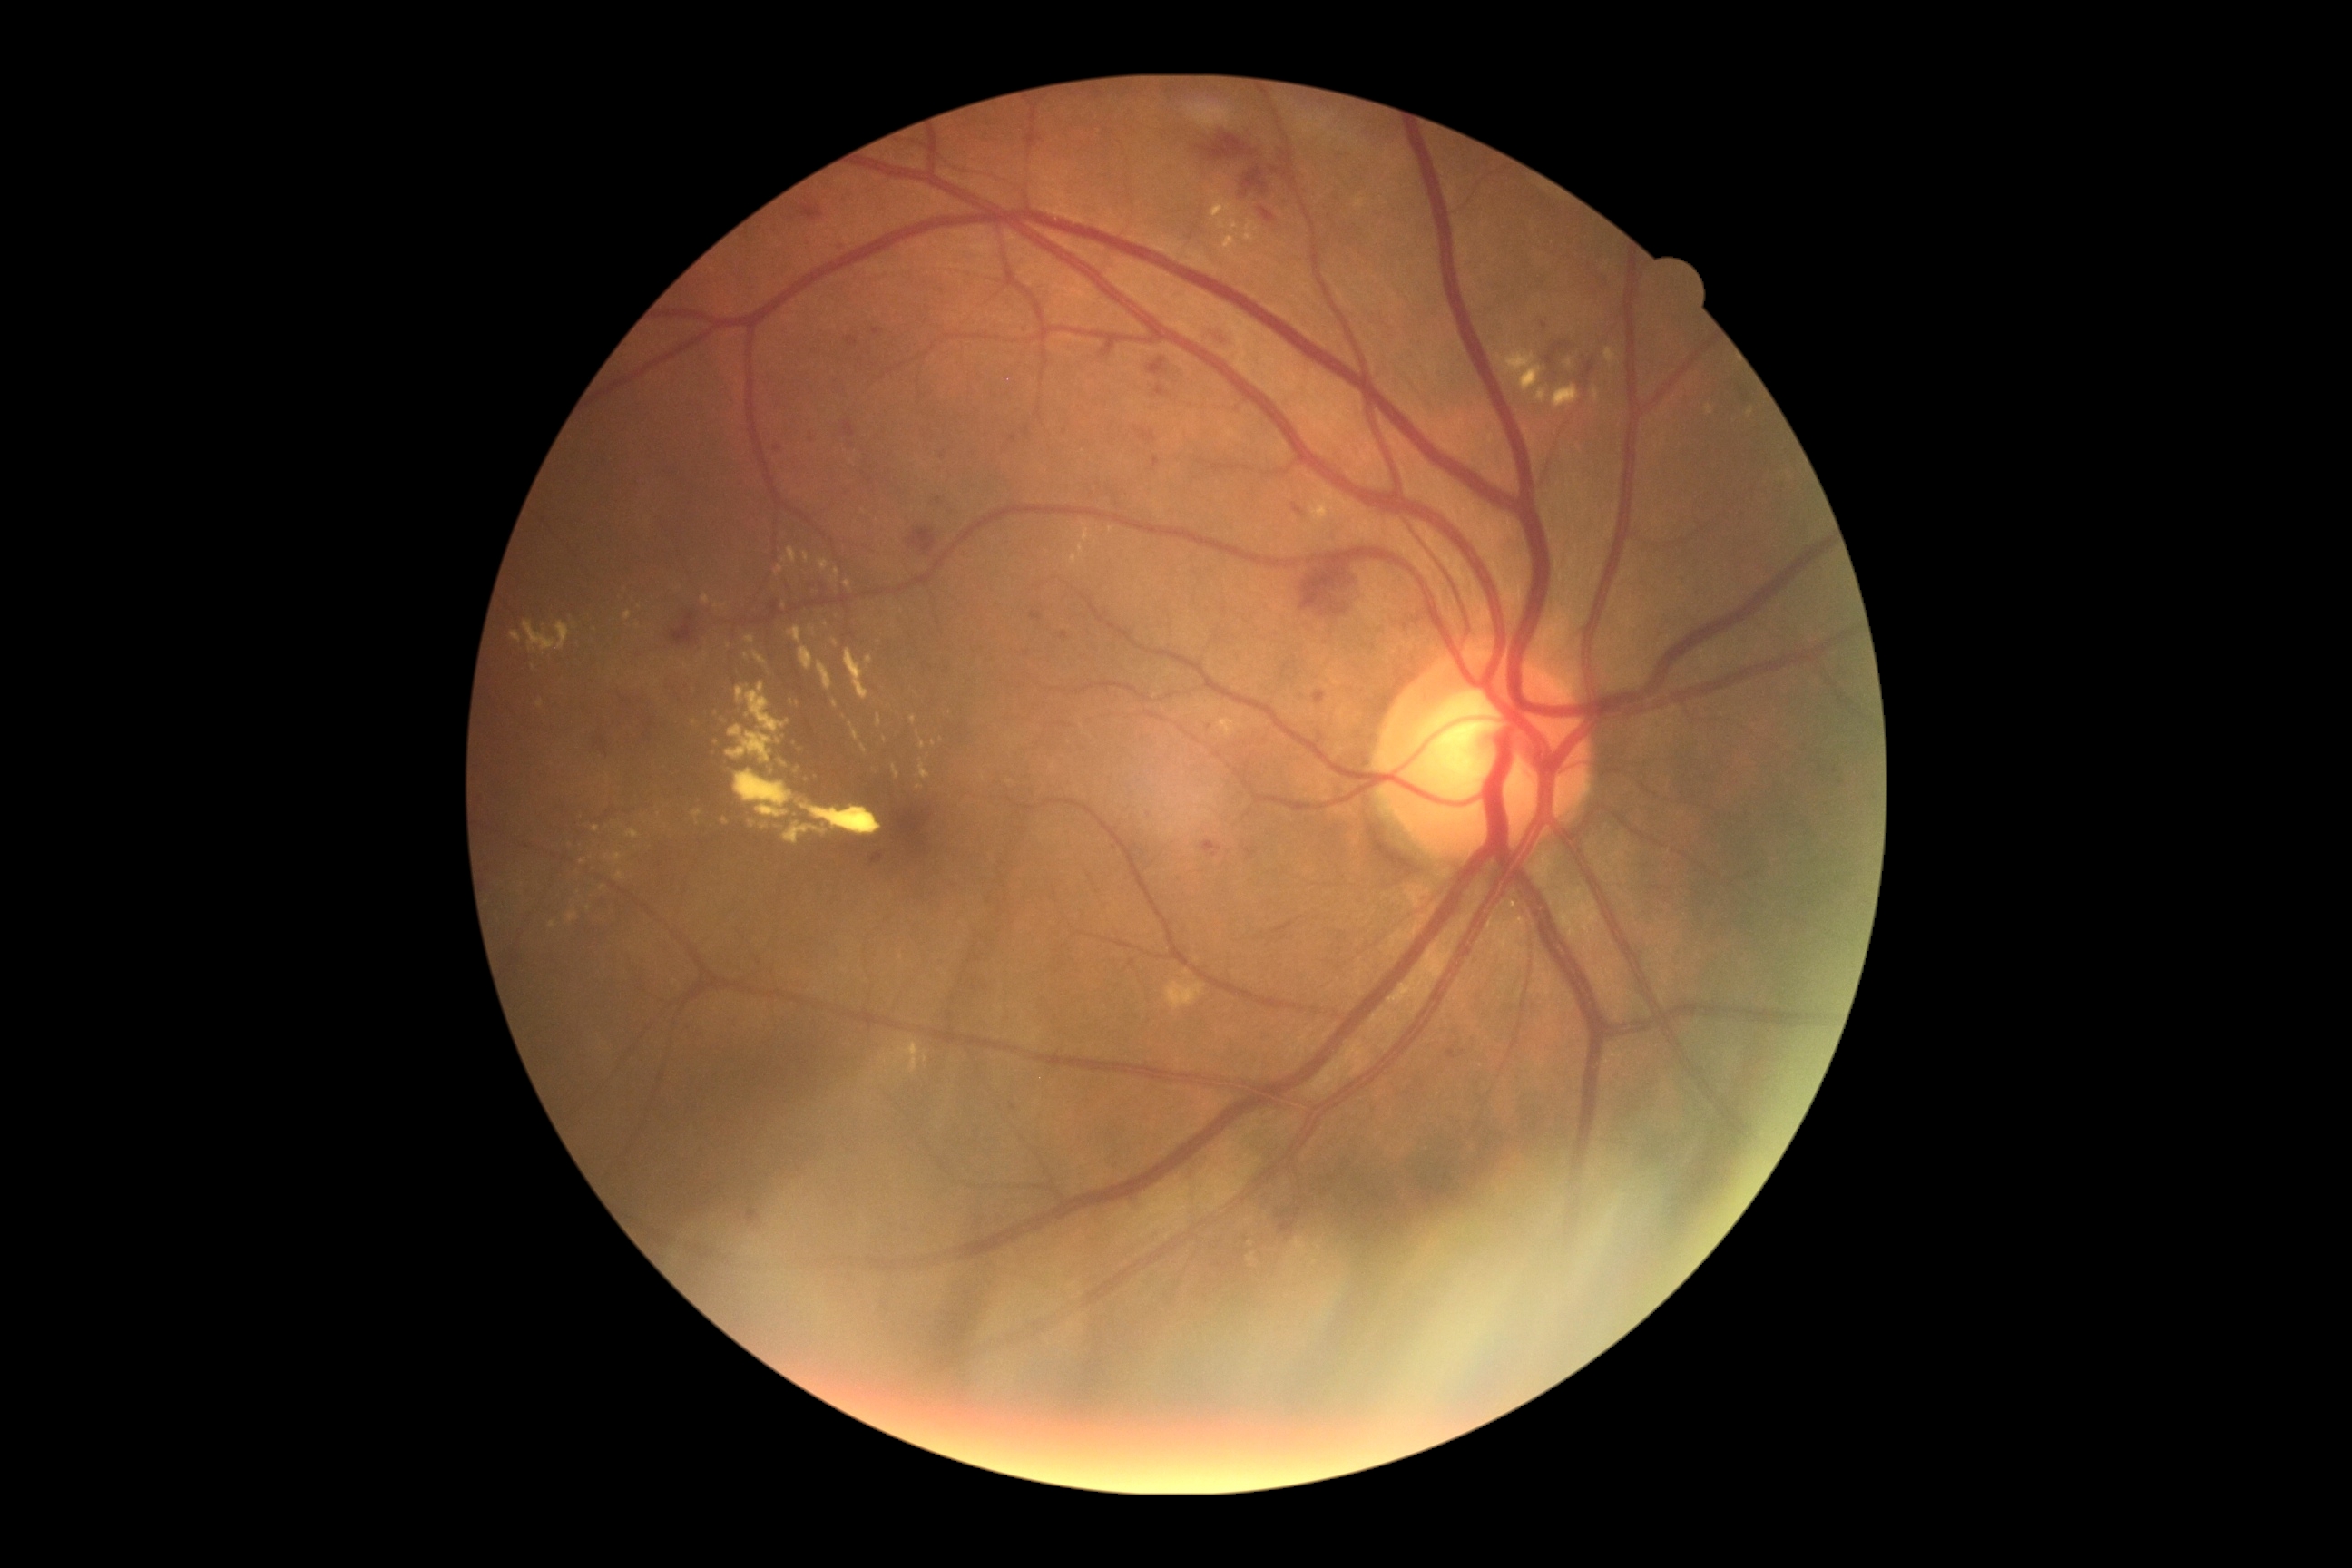 DR grade is 2/4
Lesions identified (partial list):
• EXs (subset): l=511, t=632, r=522, b=643, l=910, t=716, r=916, b=725, l=1070, t=554, r=1077, b=565, l=776, t=565, r=785, b=576, l=867, t=656, r=874, b=665, l=892, t=763, r=901, b=779, l=1536, t=387, r=1578, b=406, l=616, t=872, r=625, b=881, l=1525, t=369, r=1542, b=387, l=850, t=723, r=861, b=741, l=801, t=805, r=883, b=836
• Additional small EXs near [920,788], [552,926], [779,741], [753,824], [801,750], [534,667]